Posterior pole photograph · no pharmacologic dilation:
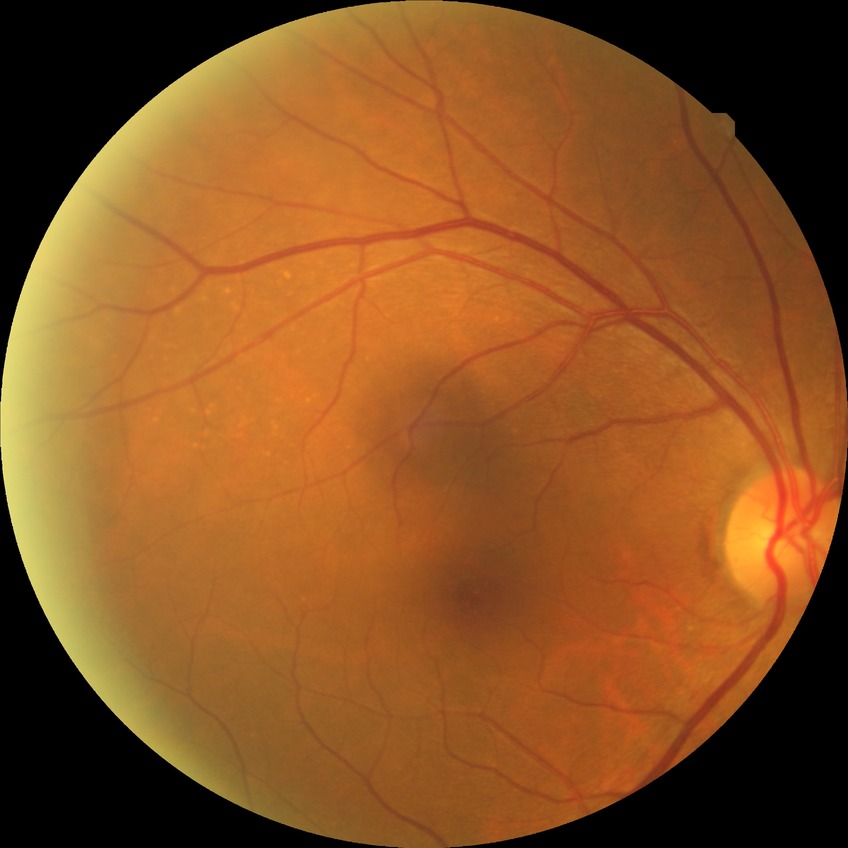

{"davis_grade": "no diabetic retinopathy"}